Fundus photo taken with a portable handheld camera: 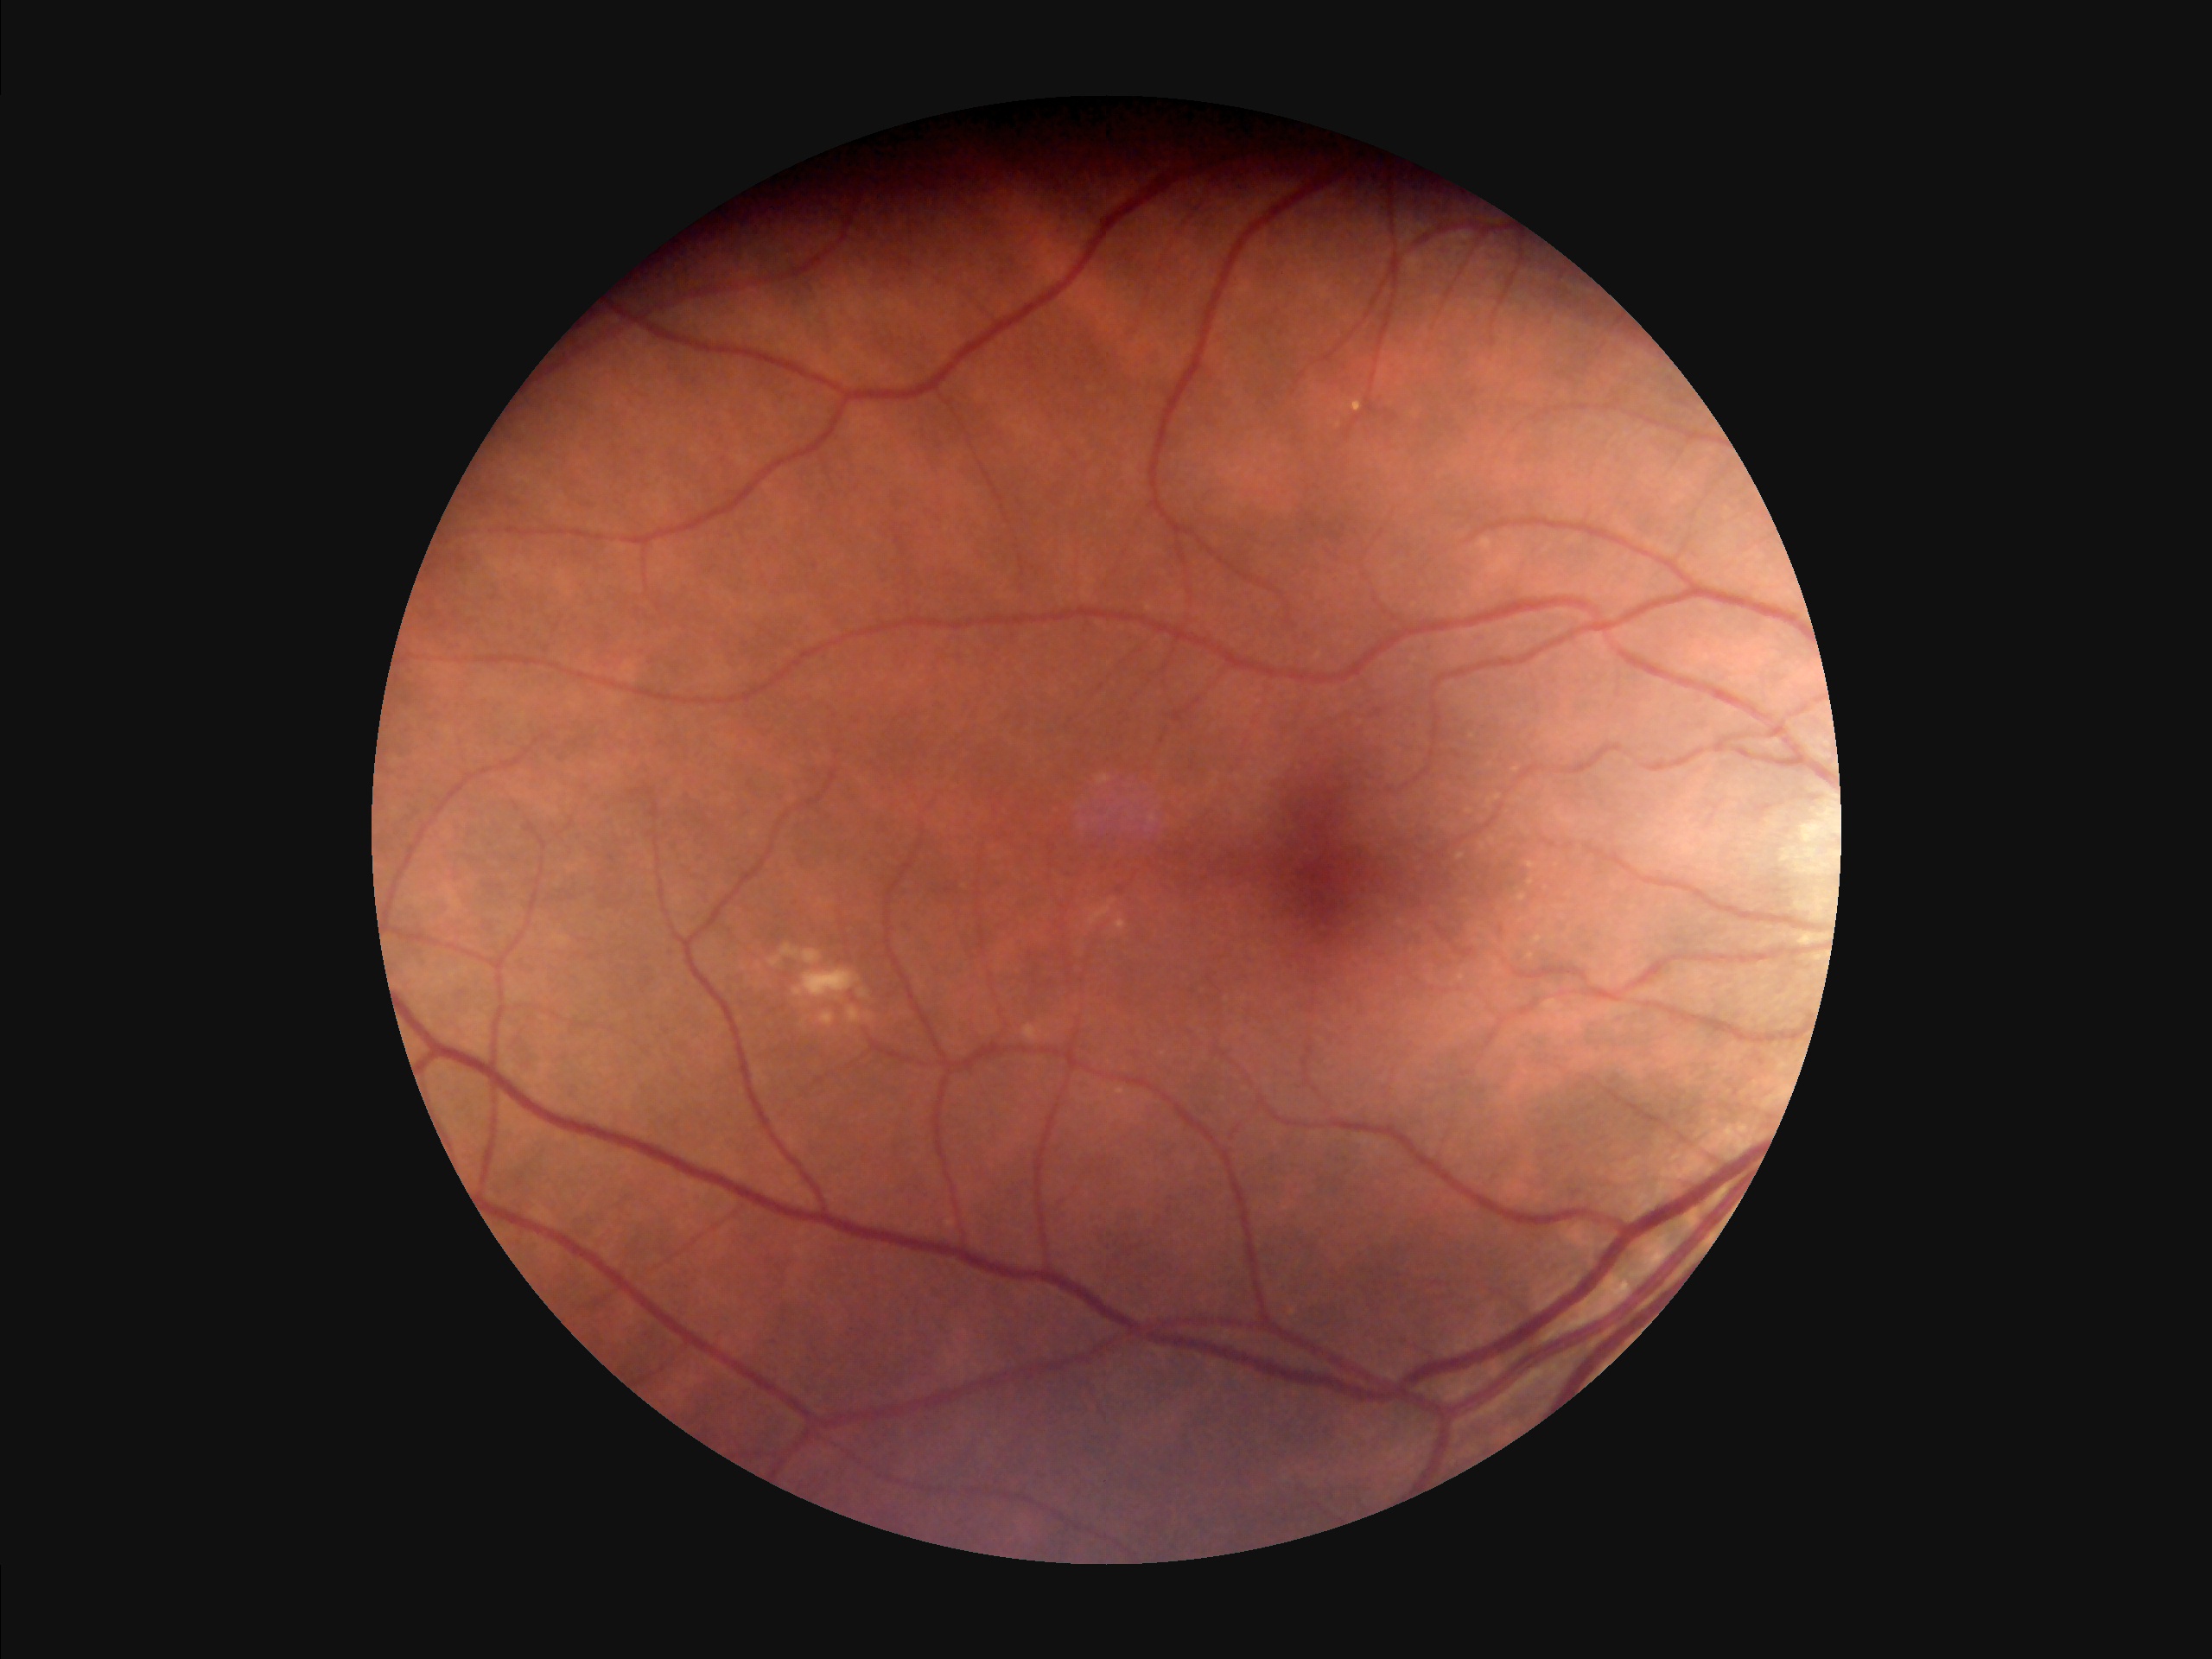
Illumination is even.
Vessels and details are readily distinguishable.
Acceptable image quality.
Noticeable blur in the optic disc, vessels, or background.